Modified Davis classification:
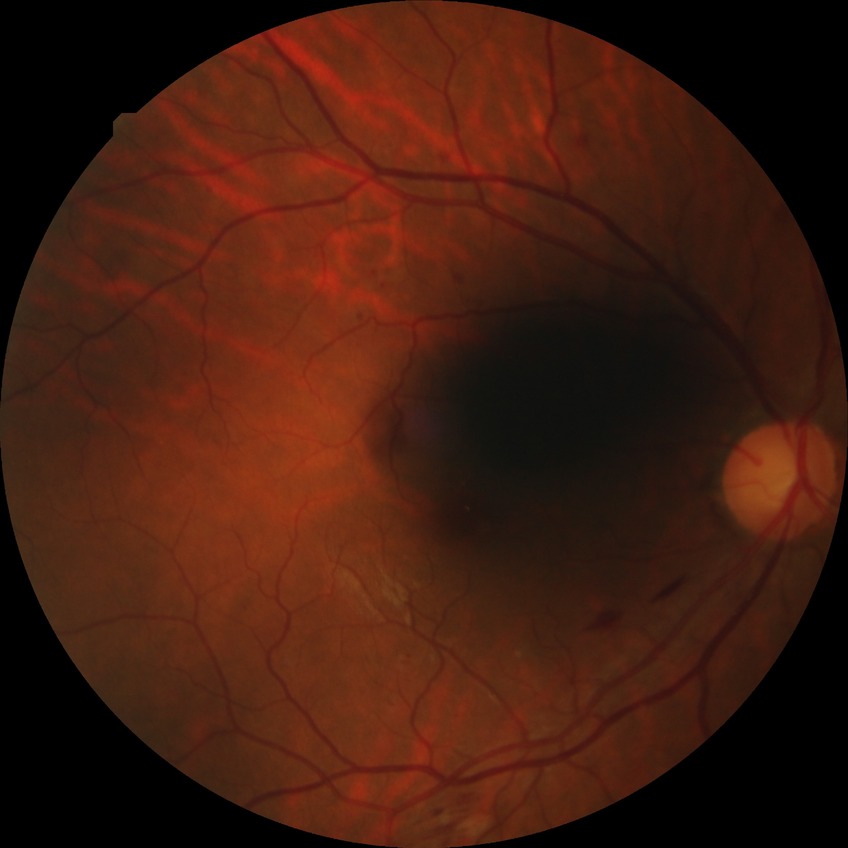
- diabetic retinopathy grade: pre-proliferative diabetic retinopathy